Modified Davis classification · without pupil dilation
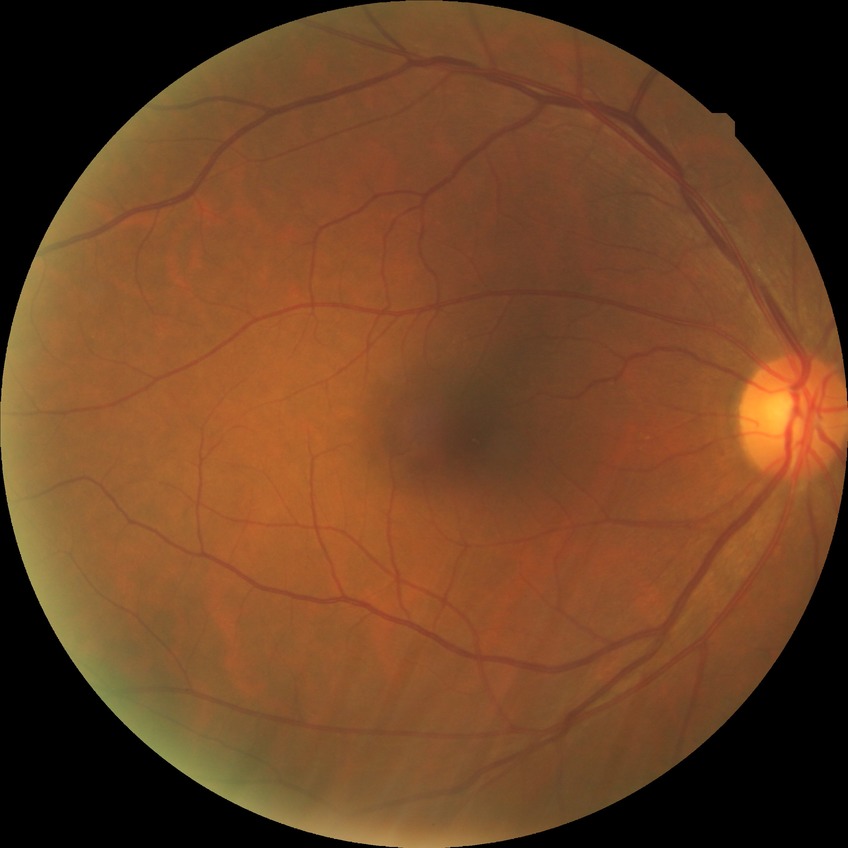 Diabetic retinopathy grade: no diabetic retinopathy.